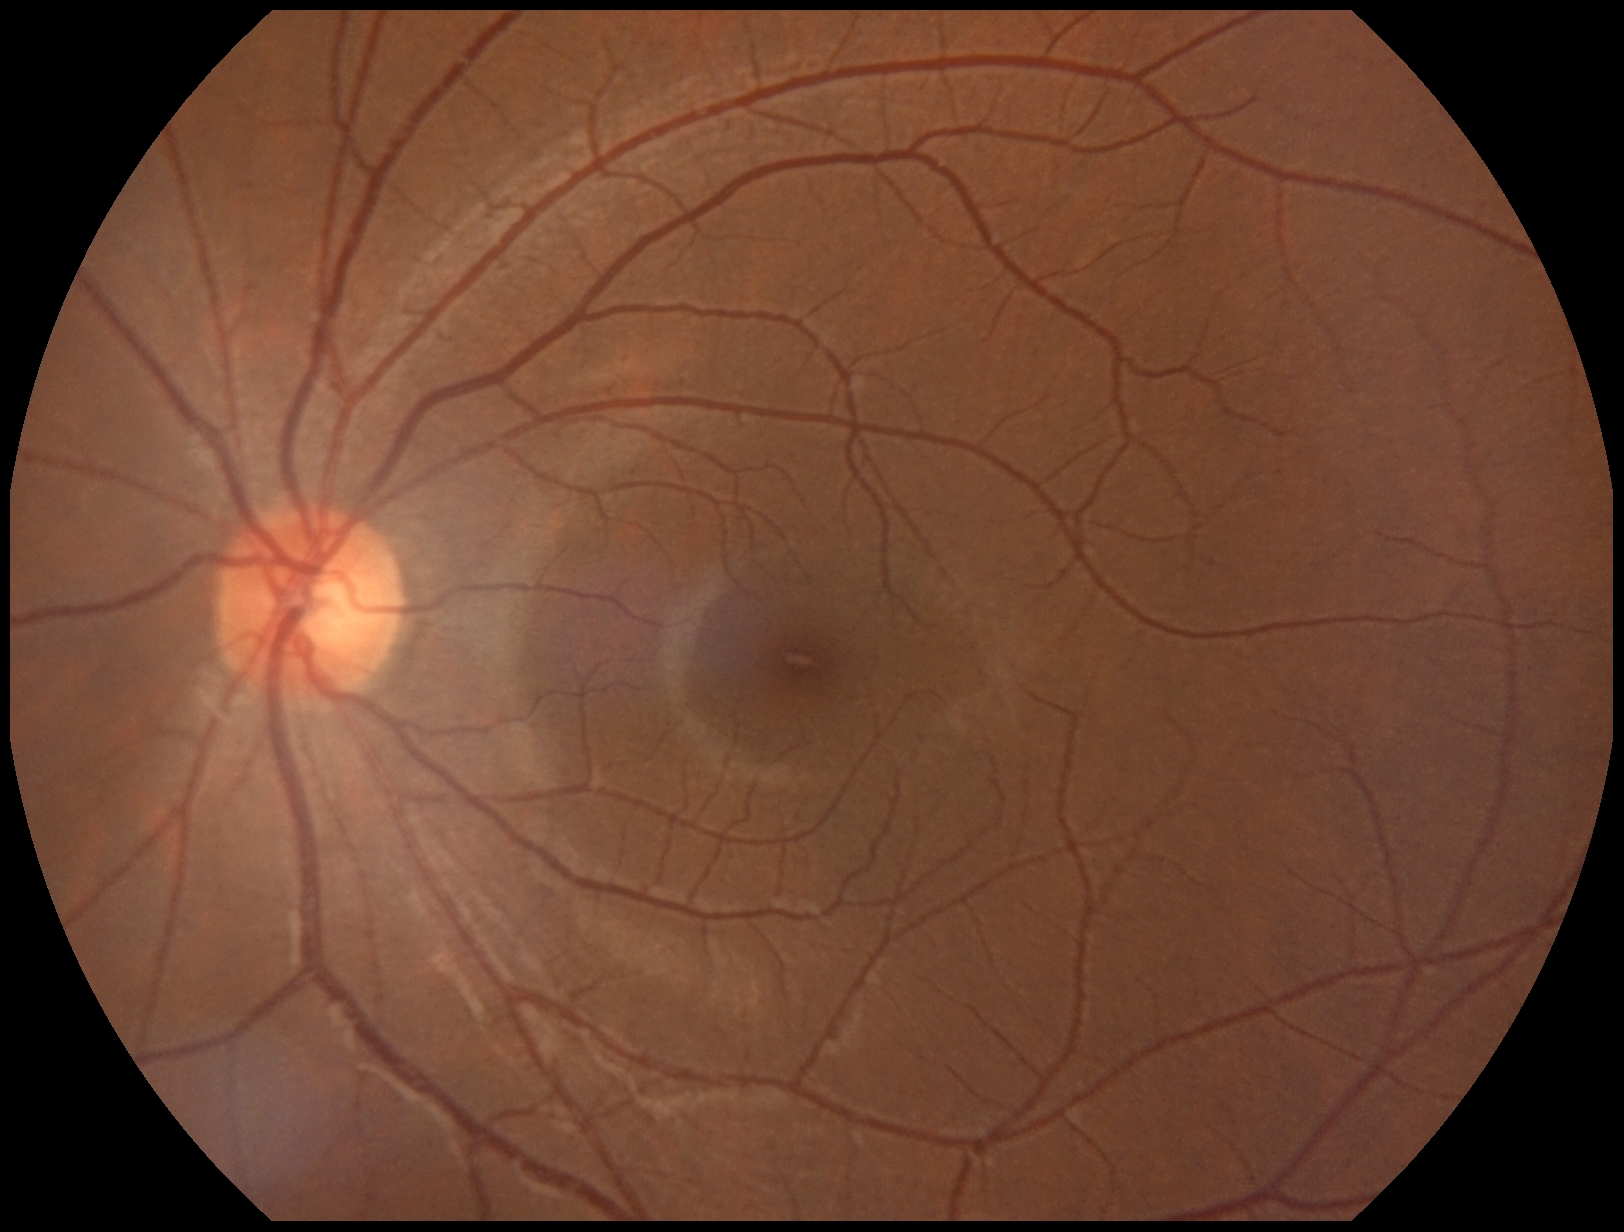

Diabetic retinopathy (DR) is 0/4 — no visible signs of diabetic retinopathy. No diabetic retinal disease findings.